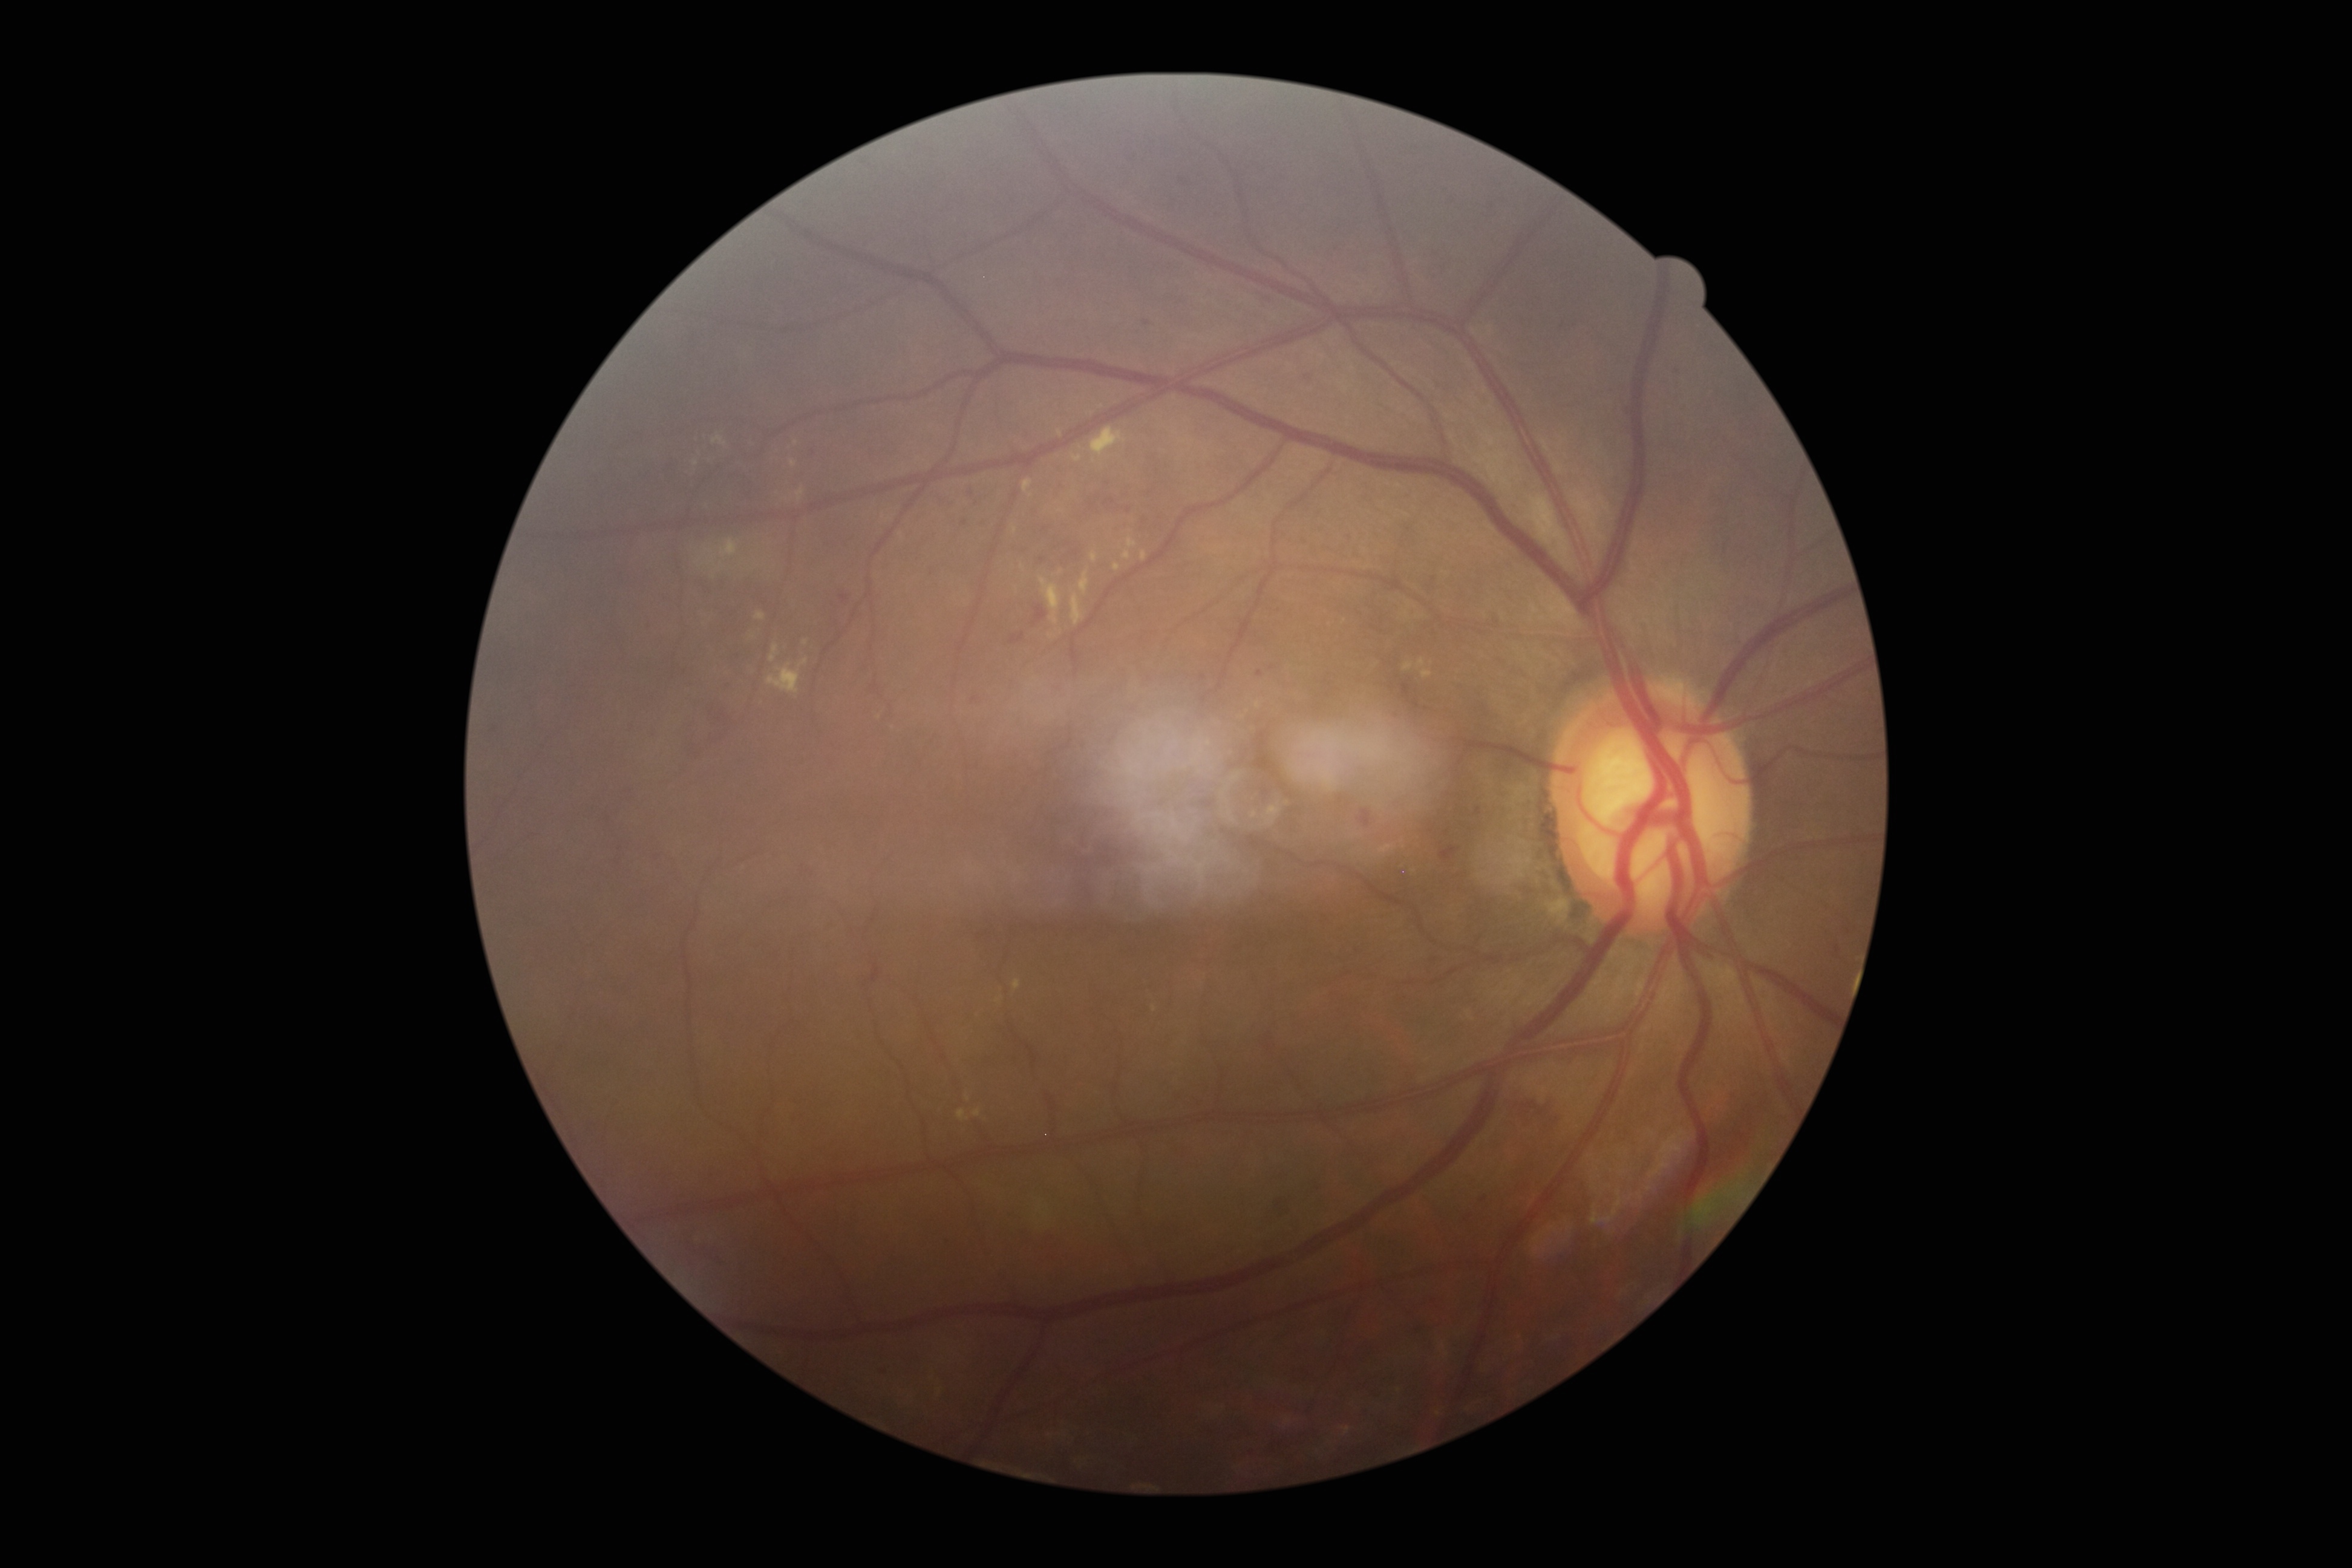

DR: moderate NPDR (grade 2); DR class: non-proliferative diabetic retinopathy.